240 by 240 pixels — 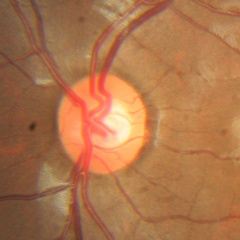 The image shows no glaucoma.